Image size 2352x1568; FOV: 45 degrees.
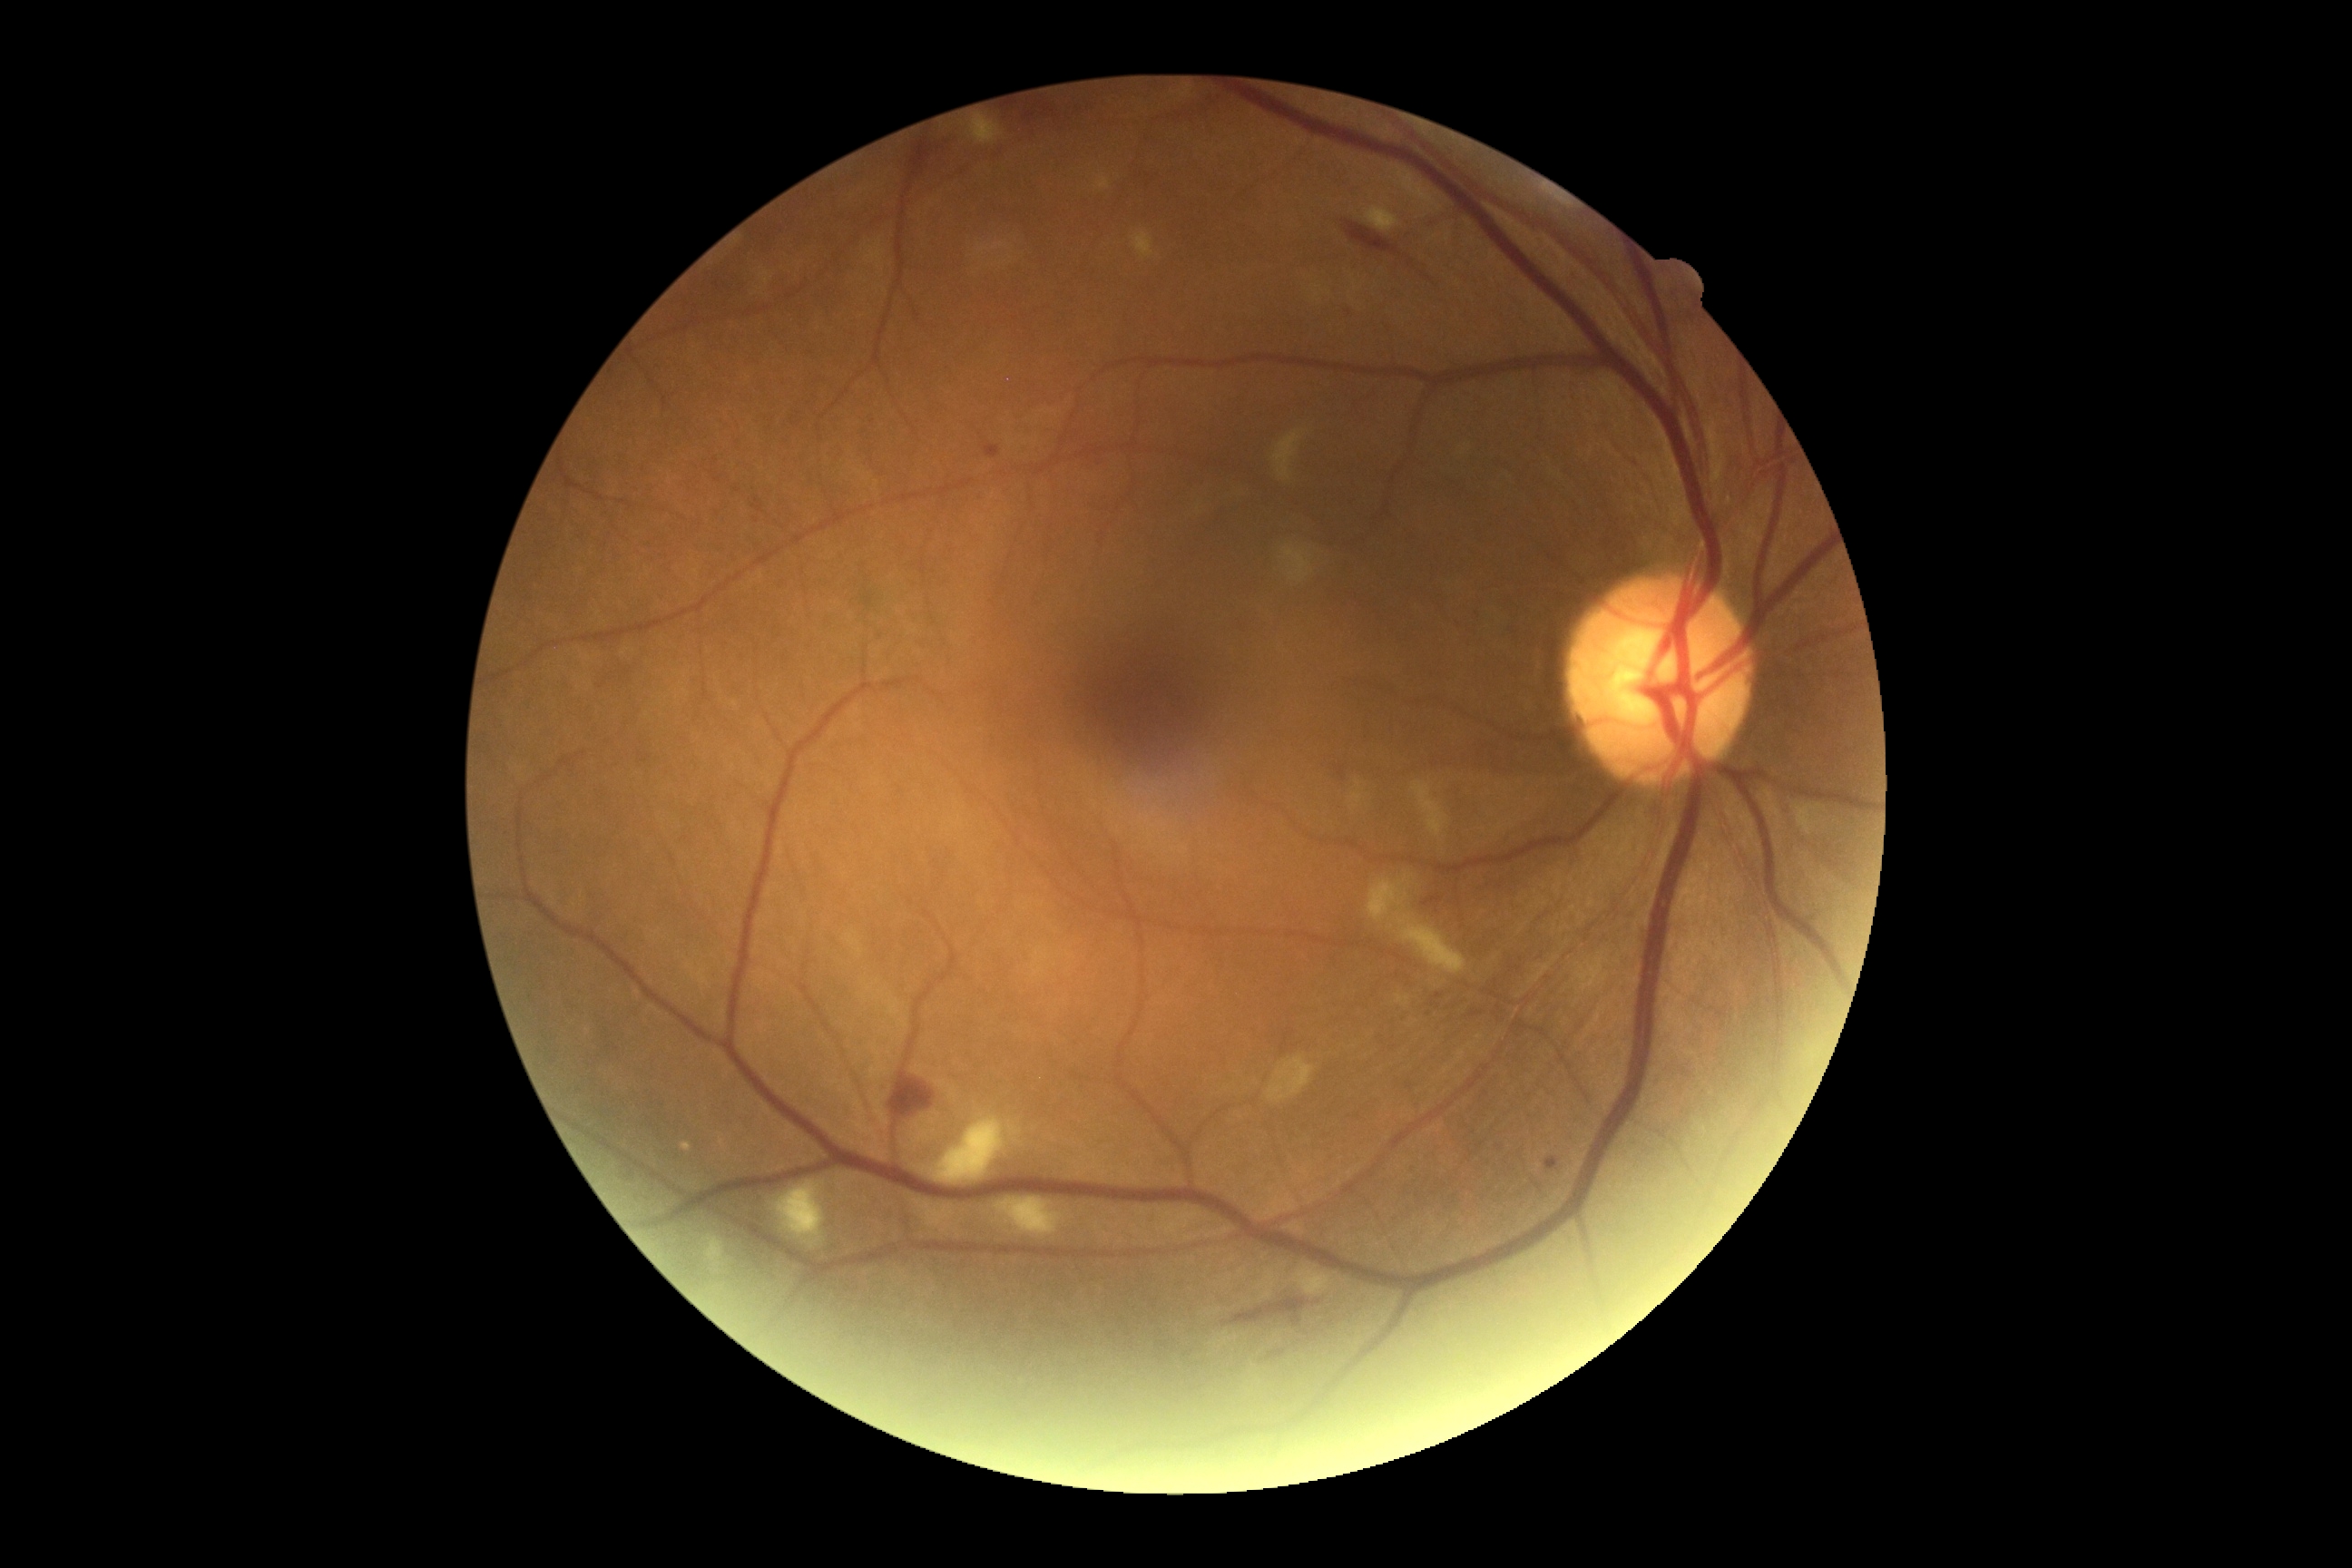 diabetic retinopathy (DR): moderate NPDR (grade 2)